Macula at the center of the field. 2361 x 1568 pixels. Captured after pupil dilation — 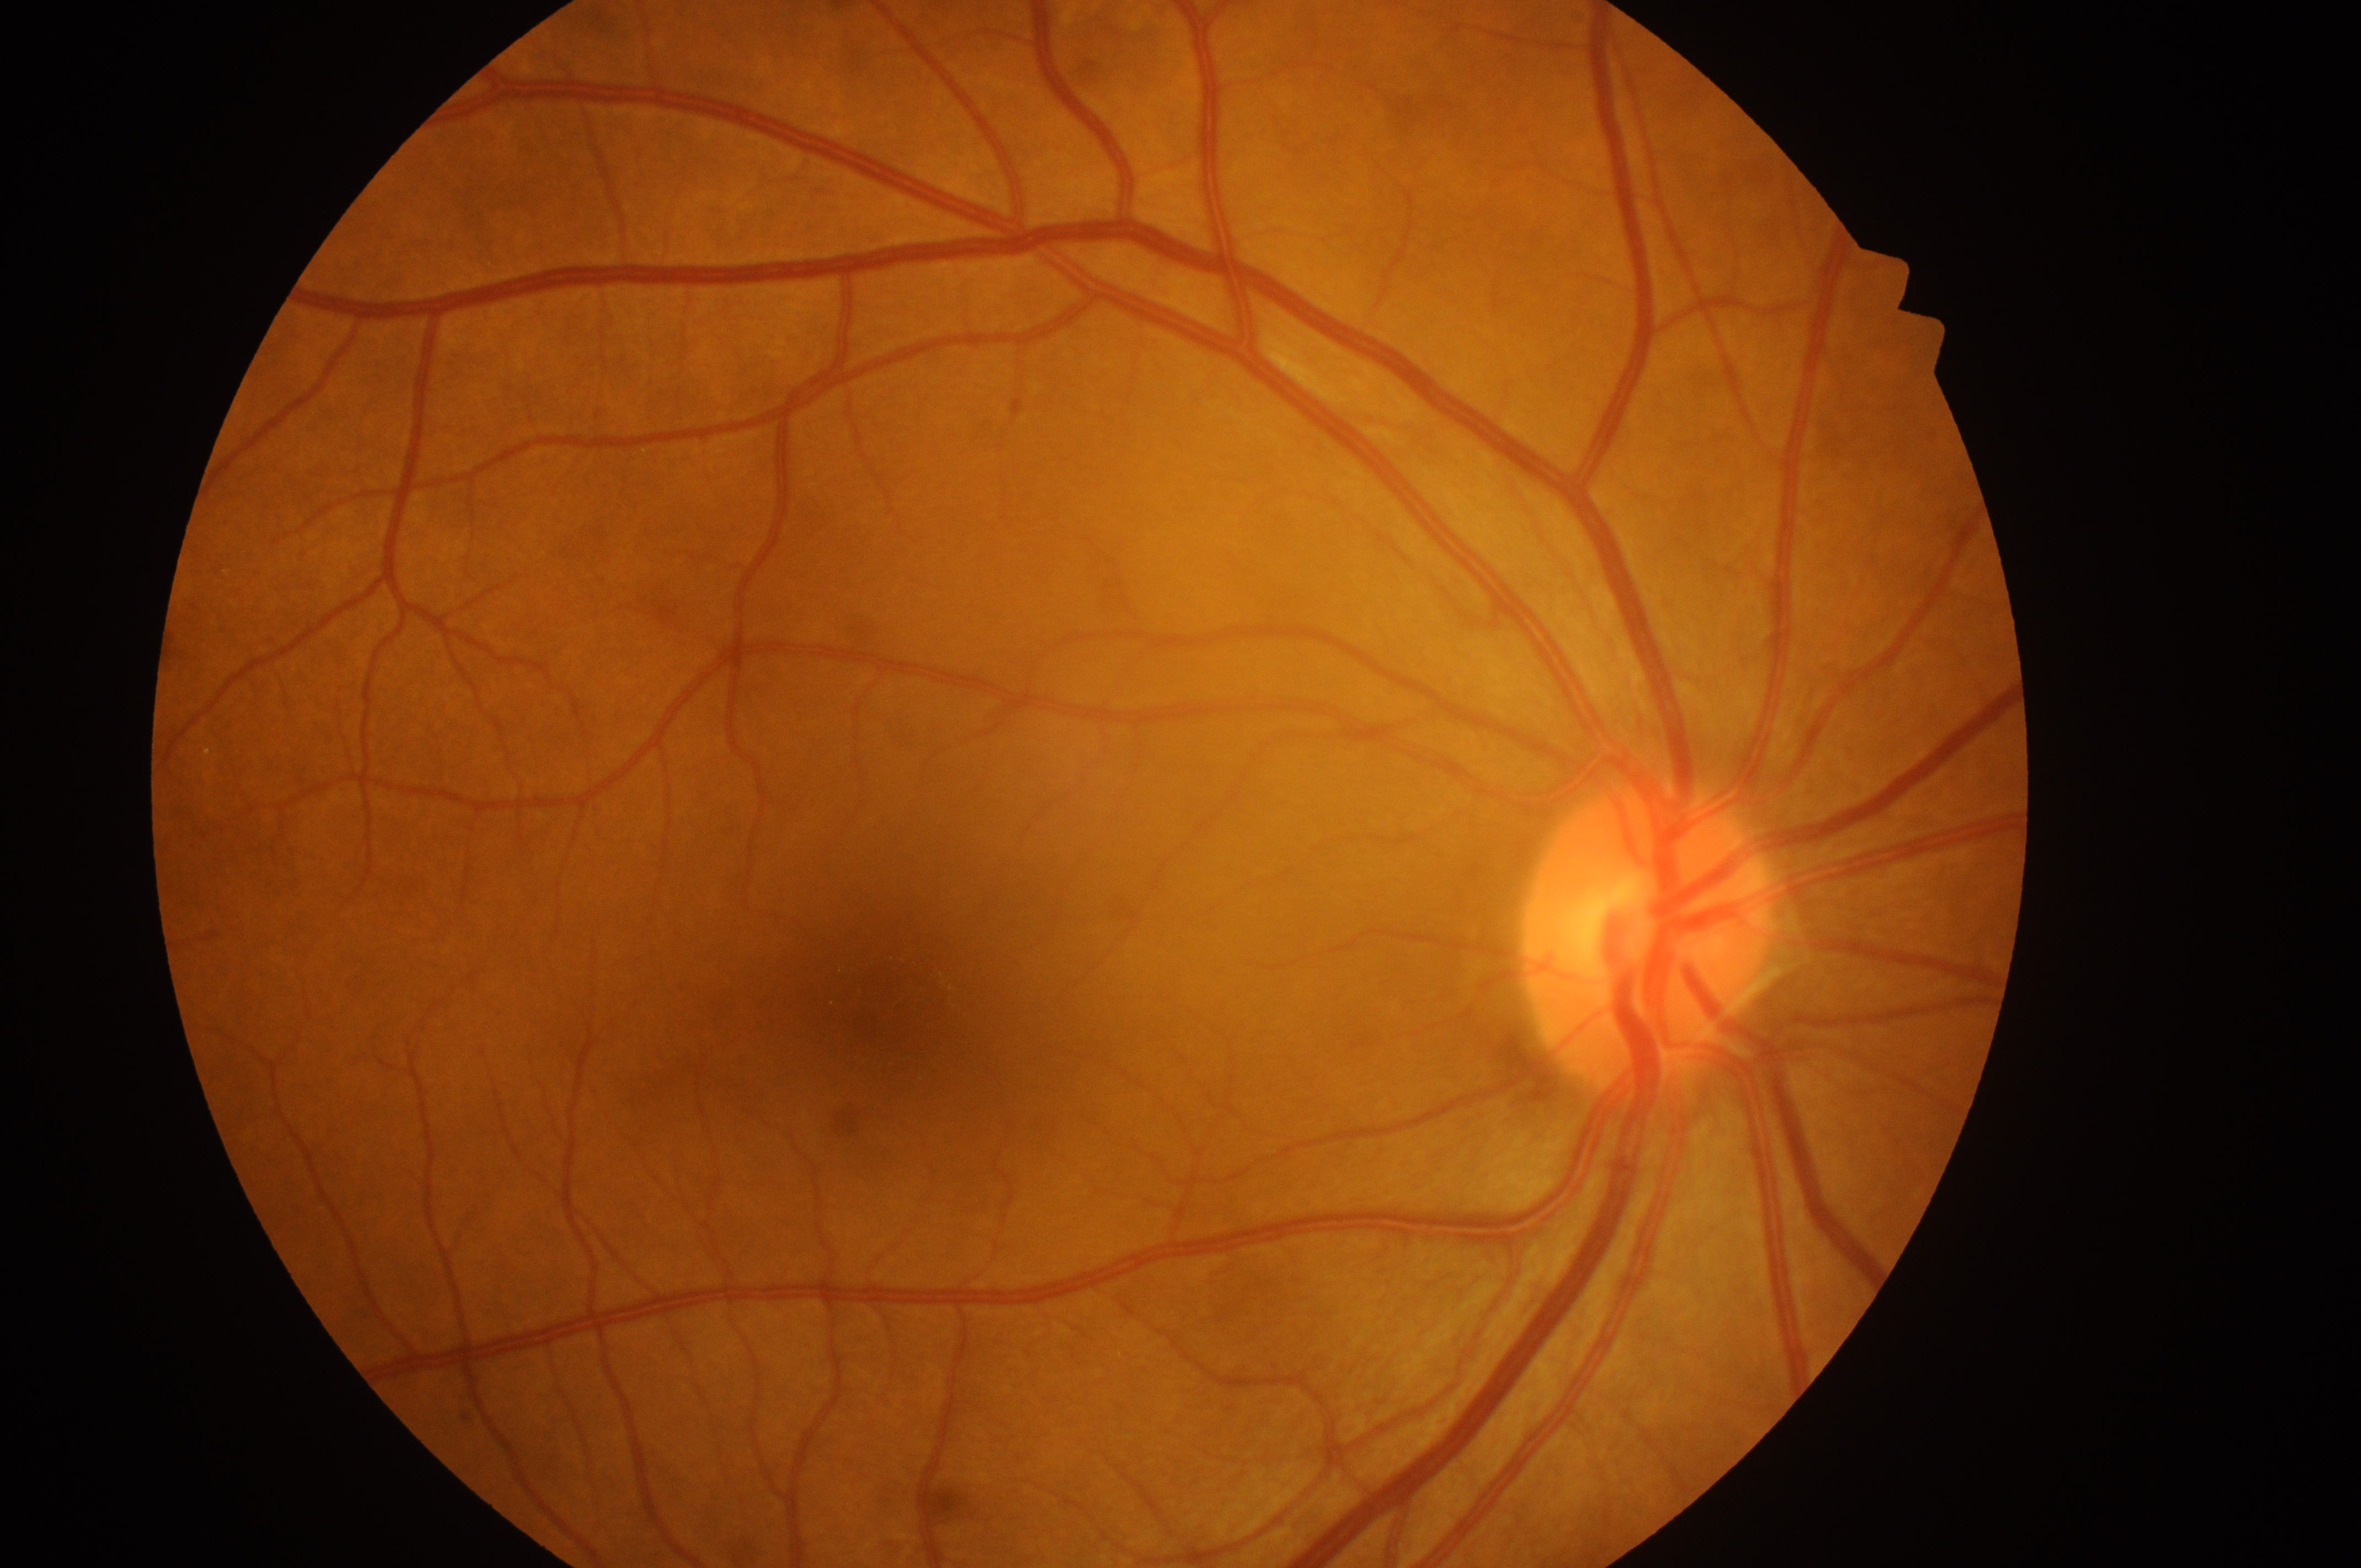 Optic nerve head: (1642,952).
Imaged eye: OD.
Diabetic macular edema (DME): no risk (grade 0).
The foveal center is at (877,1014).
Diabetic retinopathy (DR): grade 0 (no apparent retinopathy).